Modified Davis grading:
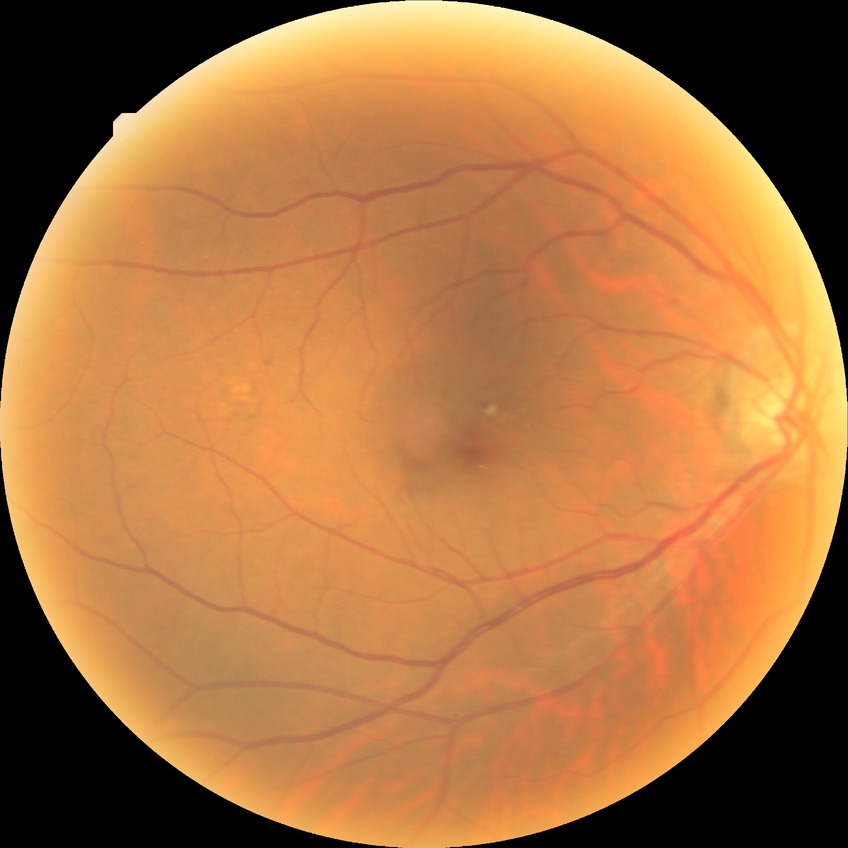
Diabetic retinopathy (DR): no diabetic retinopathy (NDR).